Retinal fundus photograph, FOV: 45 degrees.
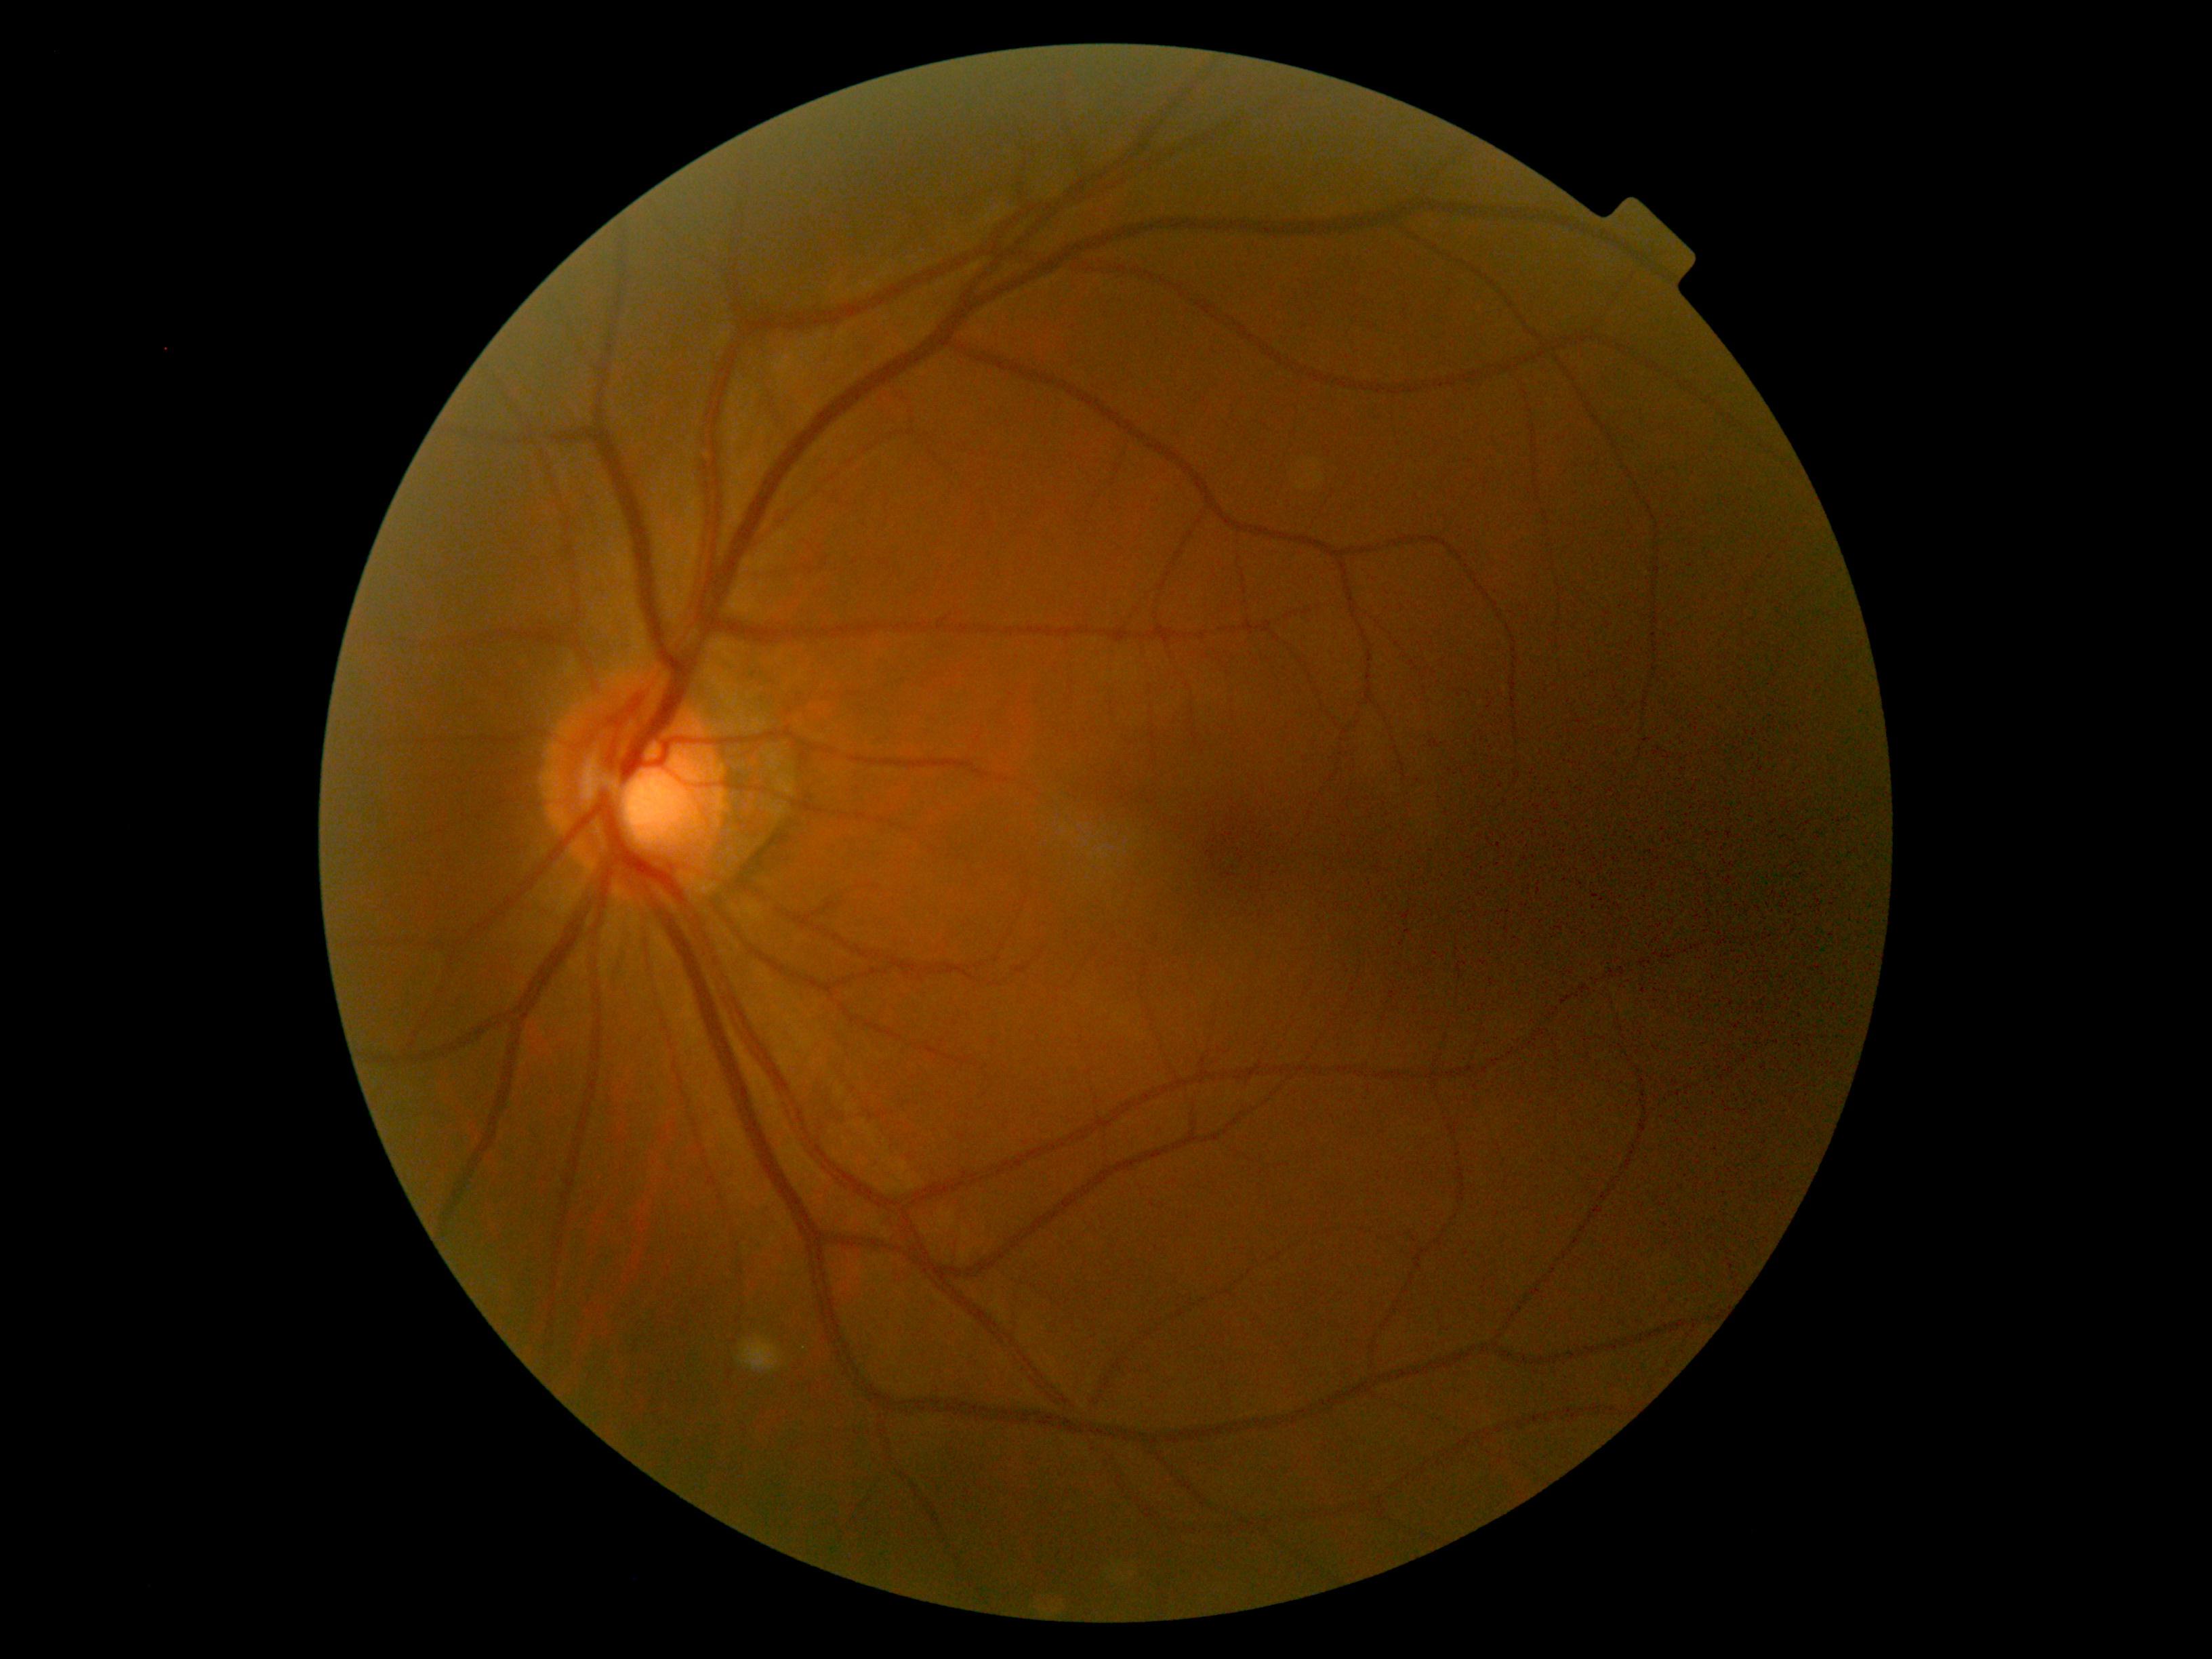 {"dr_grade": "0/4 — no visible signs of diabetic retinopathy"}